848x848 — 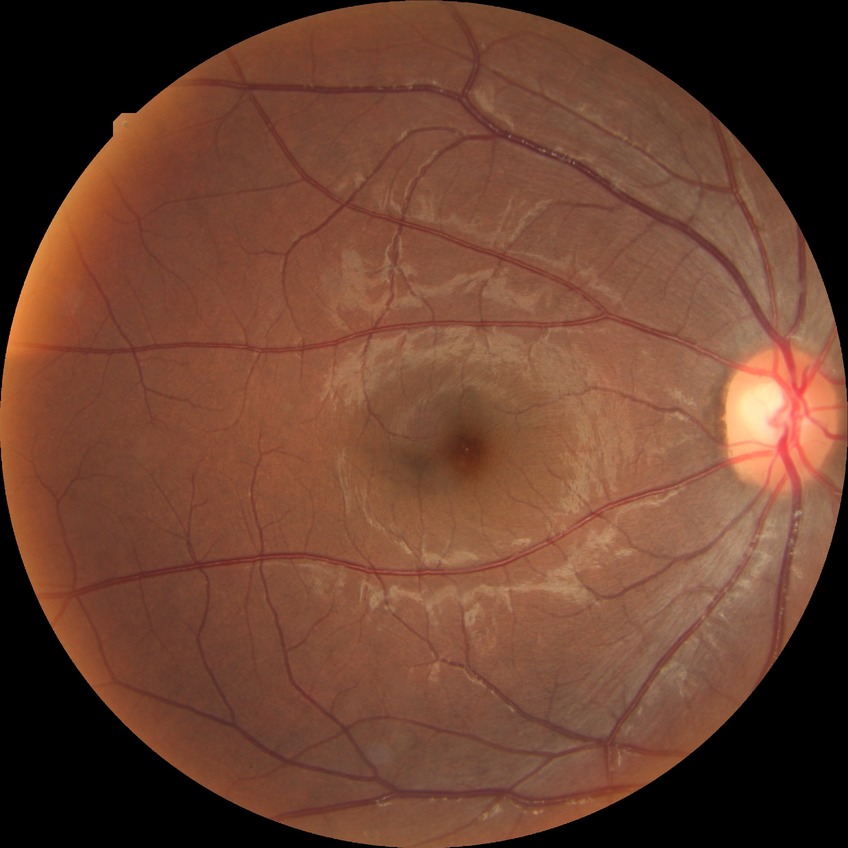

diabetic retinopathy (DR): NDR (no diabetic retinopathy).